Nonmydriatic: 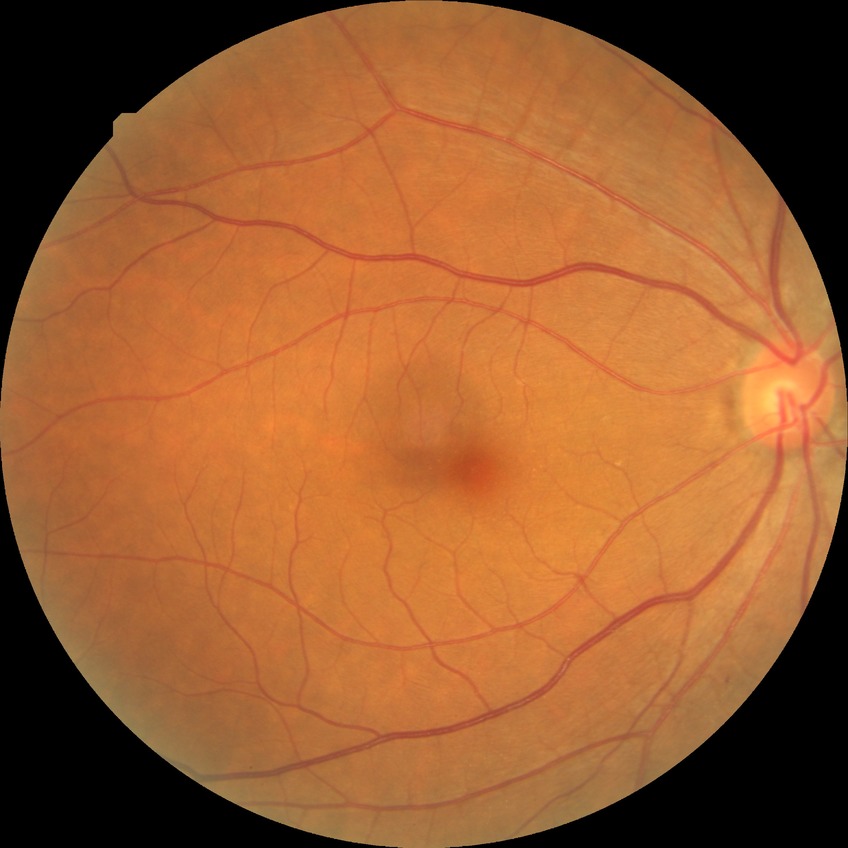
Diabetic retinopathy (DR): SDR (simple diabetic retinopathy).